Modified Davis grading: 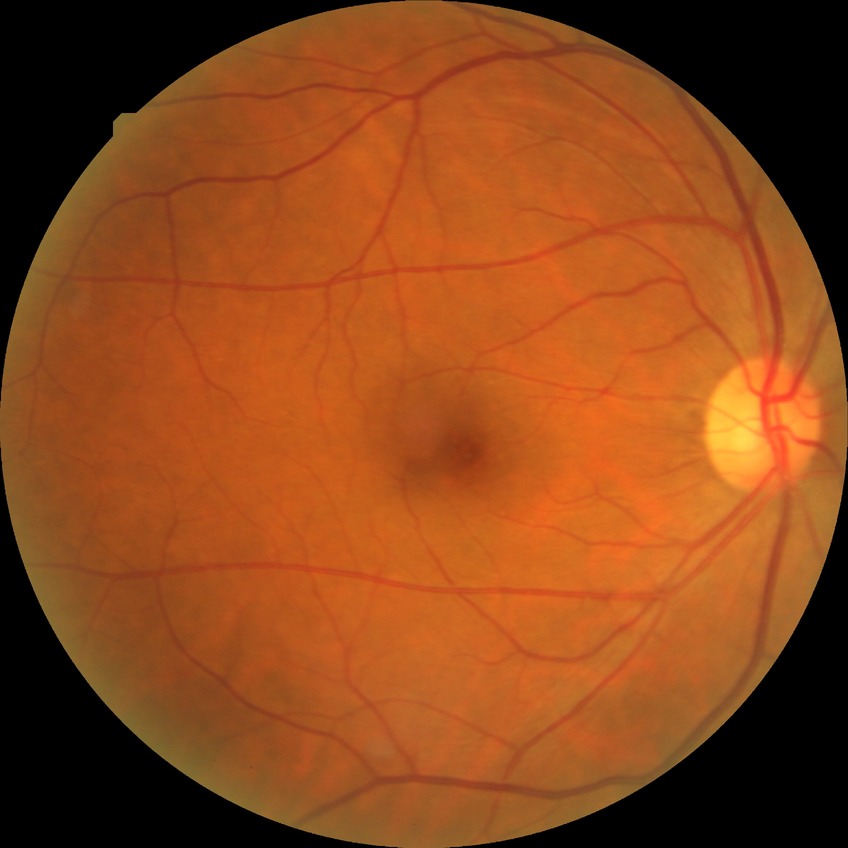
diabetic retinopathy (DR)=no diabetic retinopathy (NDR).